Retinal fundus photograph · 1932 by 1932 pixels: 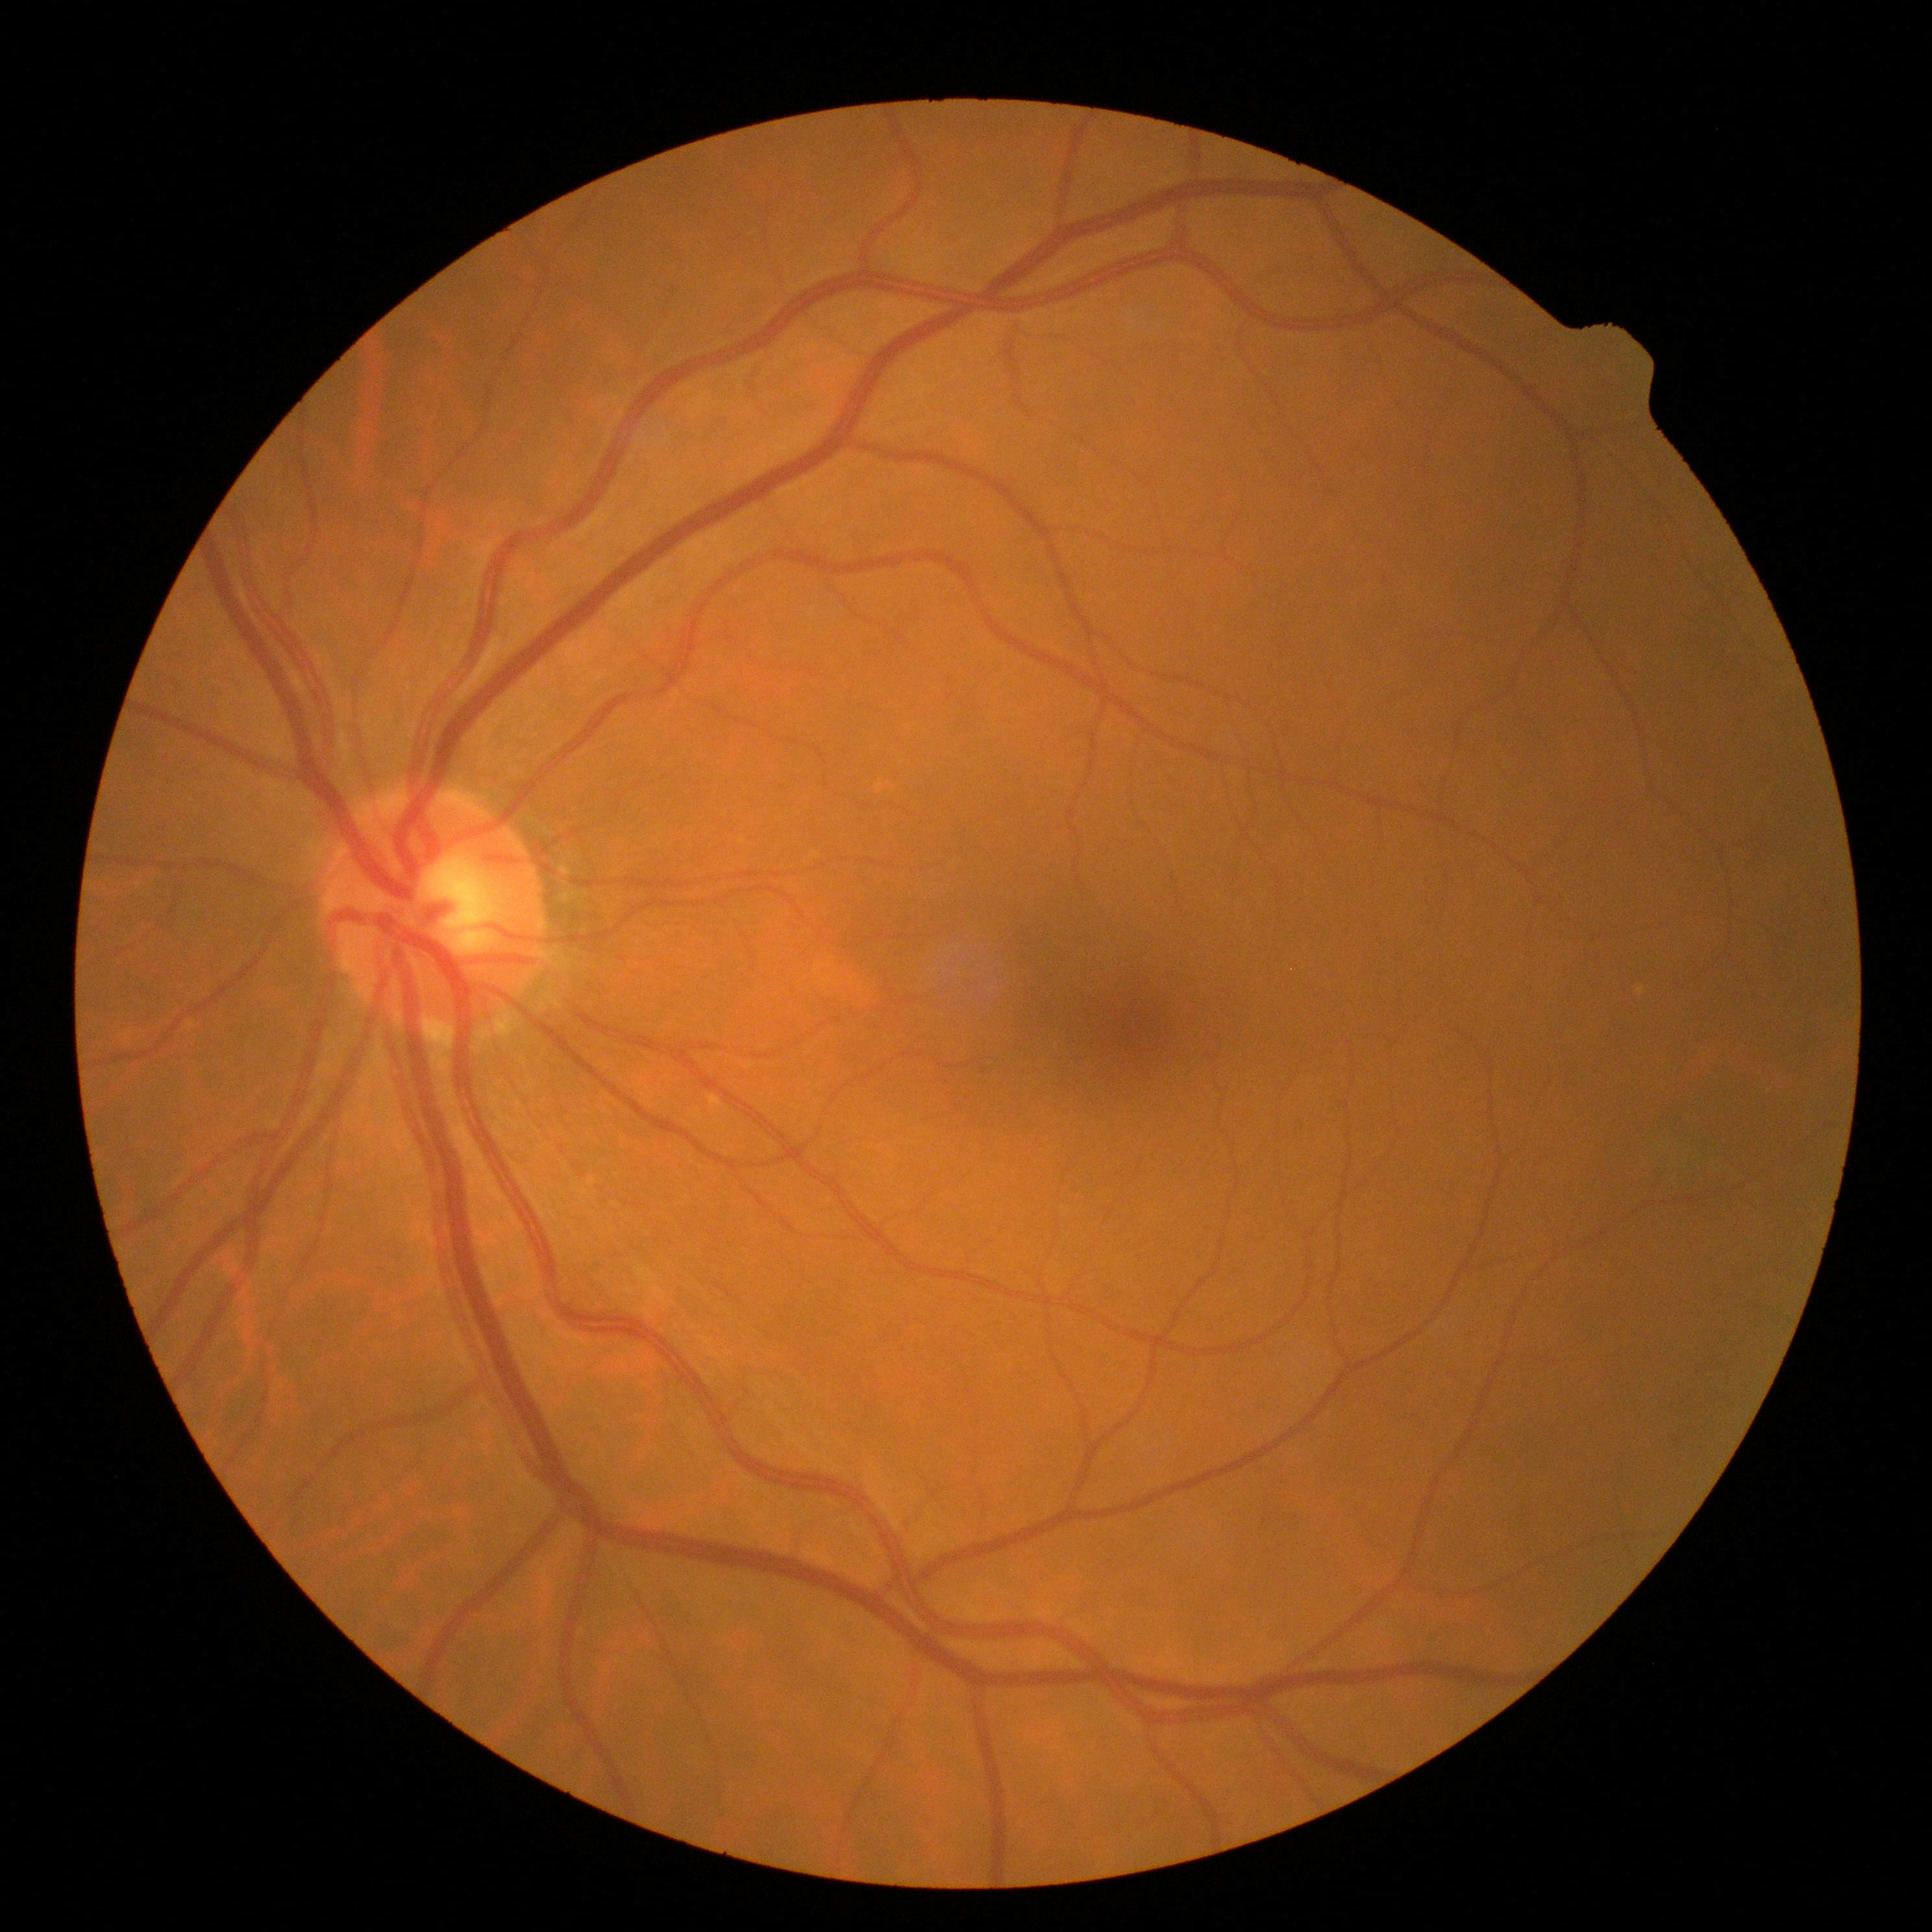 Diabetic retinopathy: no apparent diabetic retinopathy (grade 0).